2352x1568: 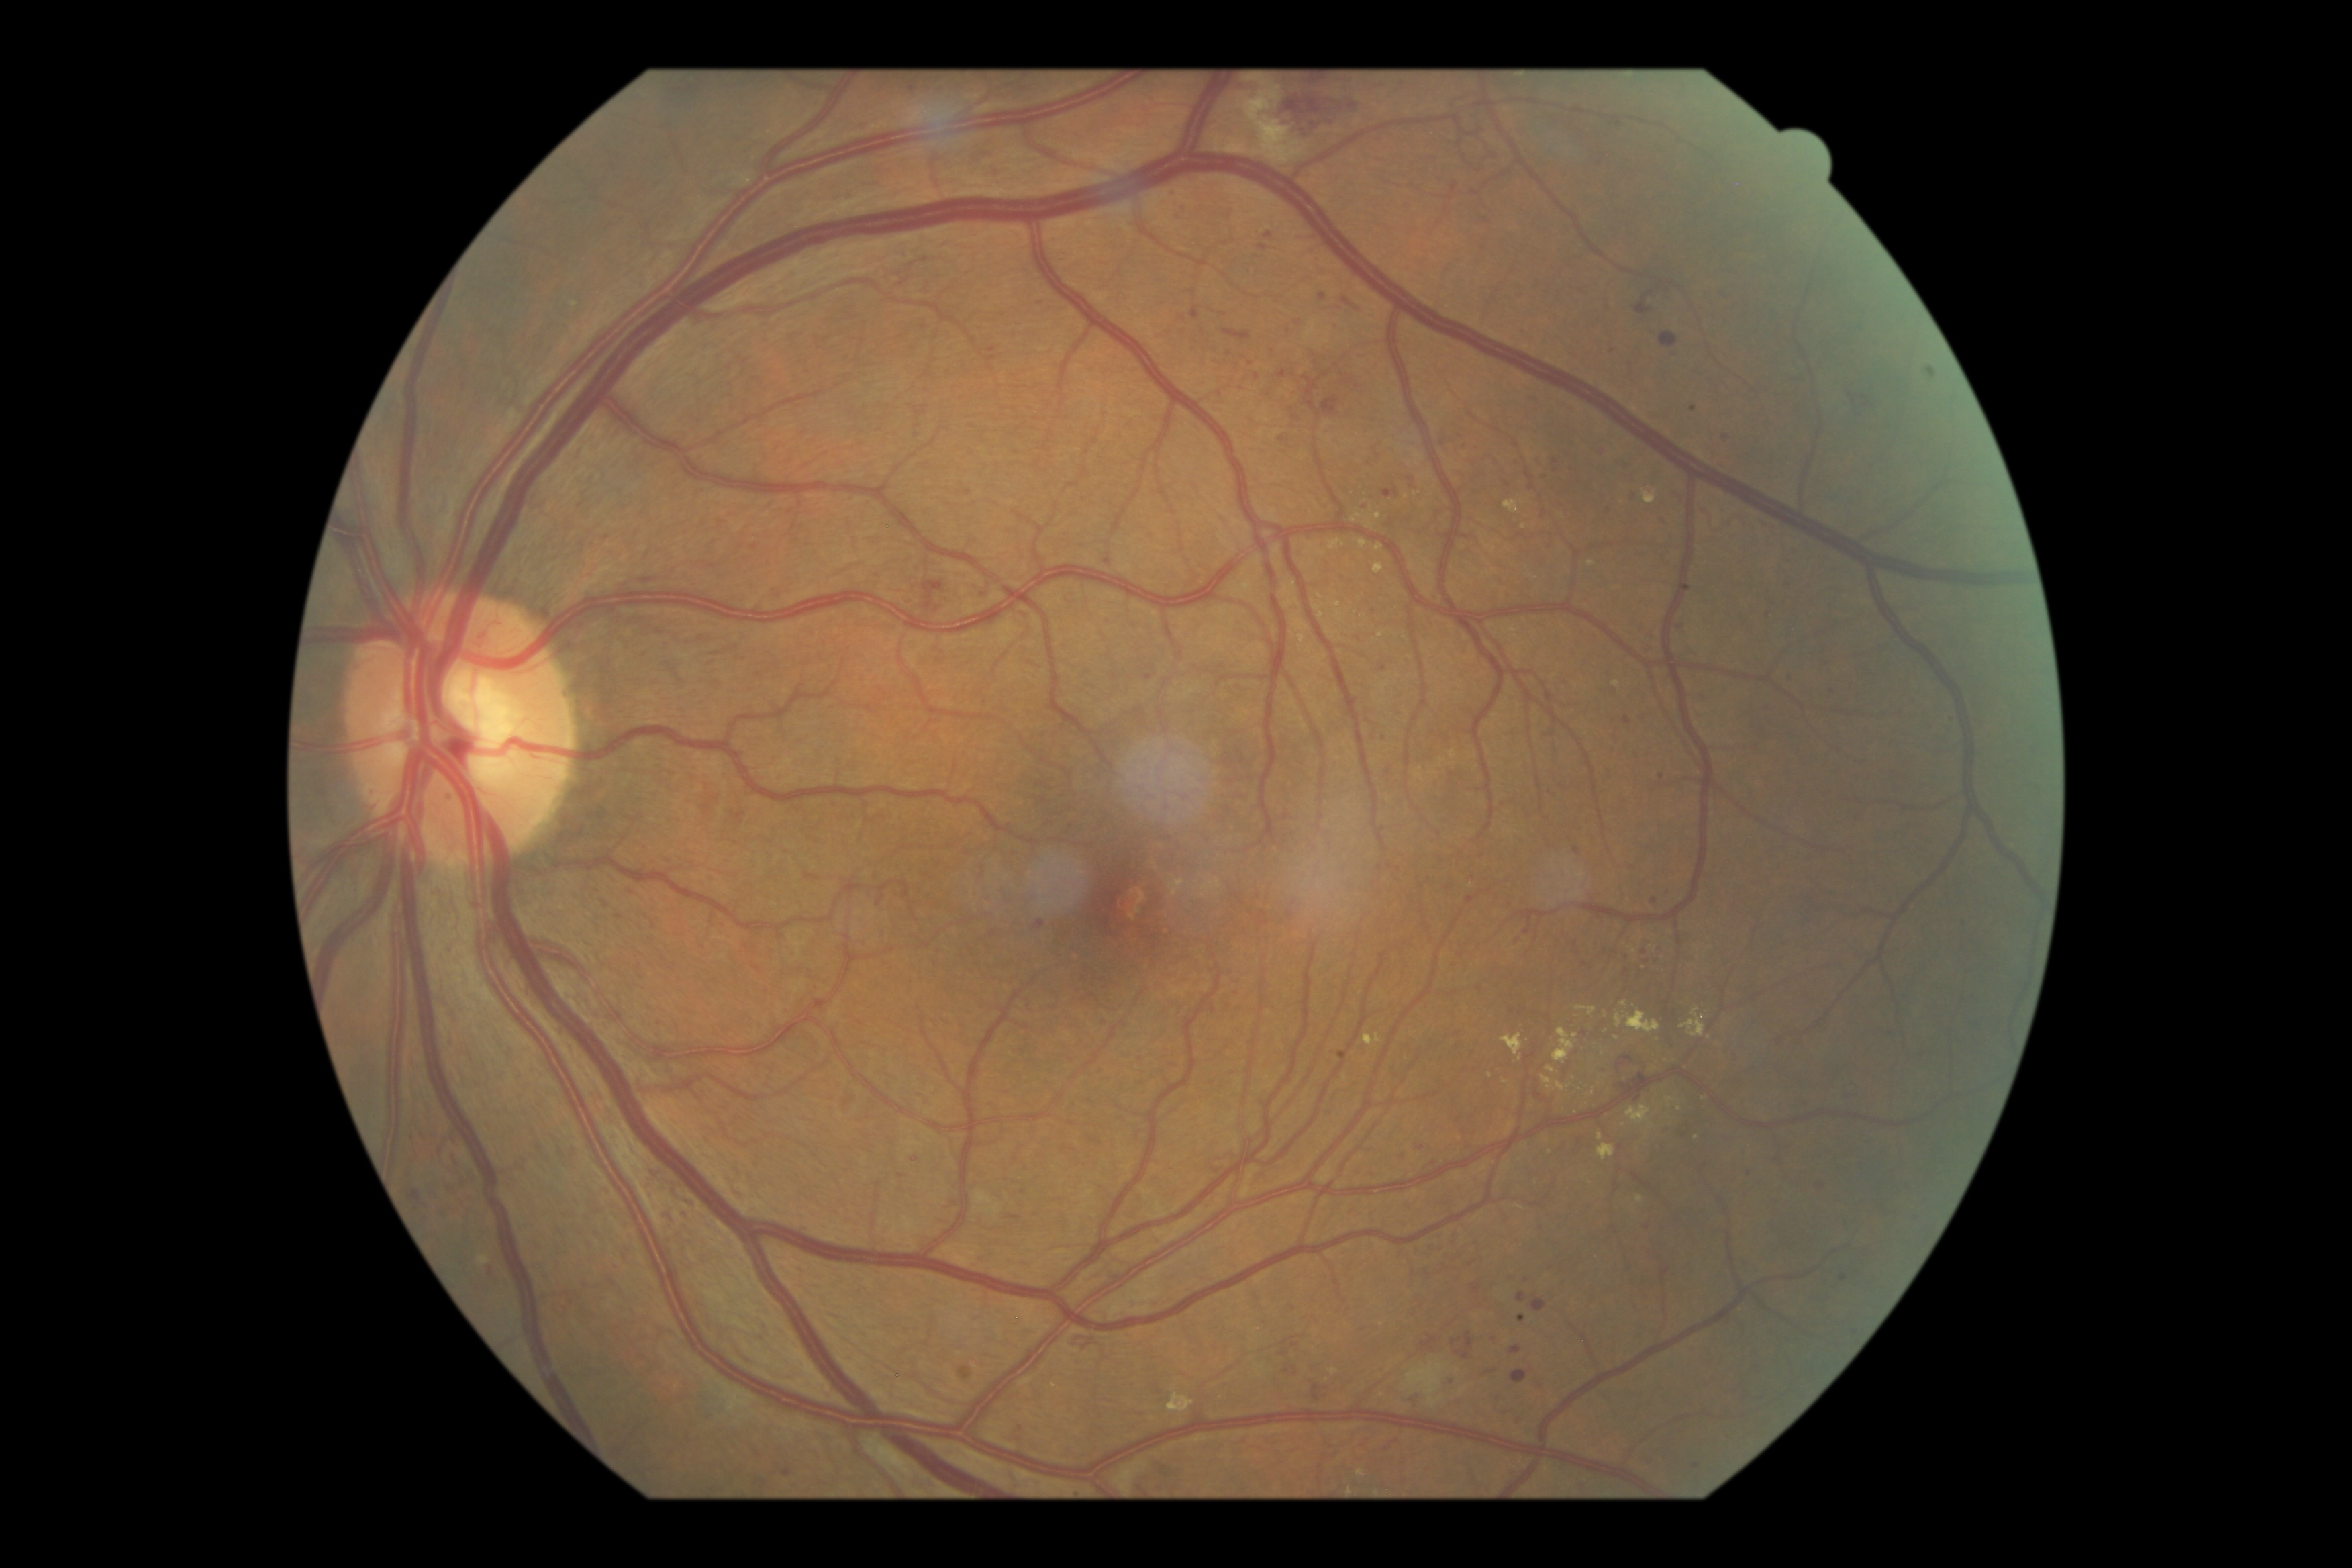
<lesions partial="true">
  <dr_grade>3</dr_grade>
  <ma partial="true">bbox=[1409, 475, 1417, 480]; bbox=[1888, 1029, 1896, 1038]; bbox=[1511, 1346, 1522, 1355]; bbox=[1451, 1375, 1457, 1385]; bbox=[966, 489, 973, 497]; bbox=[1659, 946, 1665, 954]</ma>
  <ma_small_centers>(1036, 1216); (915, 1159); (1703, 696); (1258, 377); (1295, 1346); (912, 89); (1526, 1281); (984, 703); (1542, 1227); (1697, 1466); (1183, 335); (1544, 477)</ma_small_centers>
  <ex partial="true">bbox=[1542, 1077, 1553, 1088]; bbox=[1293, 621, 1311, 646]; bbox=[1330, 540, 1346, 551]; bbox=[1318, 551, 1327, 556]; bbox=[1643, 491, 1657, 505]; bbox=[1330, 603, 1342, 609]; bbox=[1636, 1197, 1645, 1204]; bbox=[1351, 515, 1363, 523]; bbox=[1681, 1008, 1706, 1037]</ex>
  <ex_small_centers>(1361, 1474); (1618, 1039); (1505, 1082); (1381, 636); (1524, 527)</ex_small_centers>
</lesions>